Nonmydriatic. Posterior pole color fundus photograph
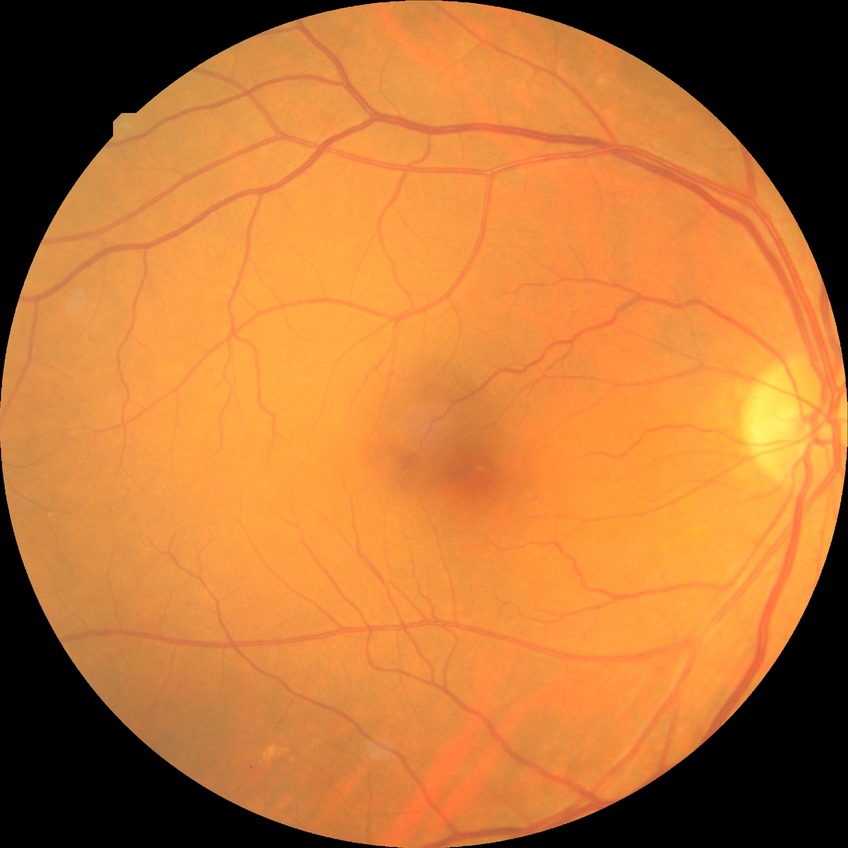 Assessment:
- diabetic retinopathy (DR): no diabetic retinopathy (NDR)